Infant wide-field retinal image — 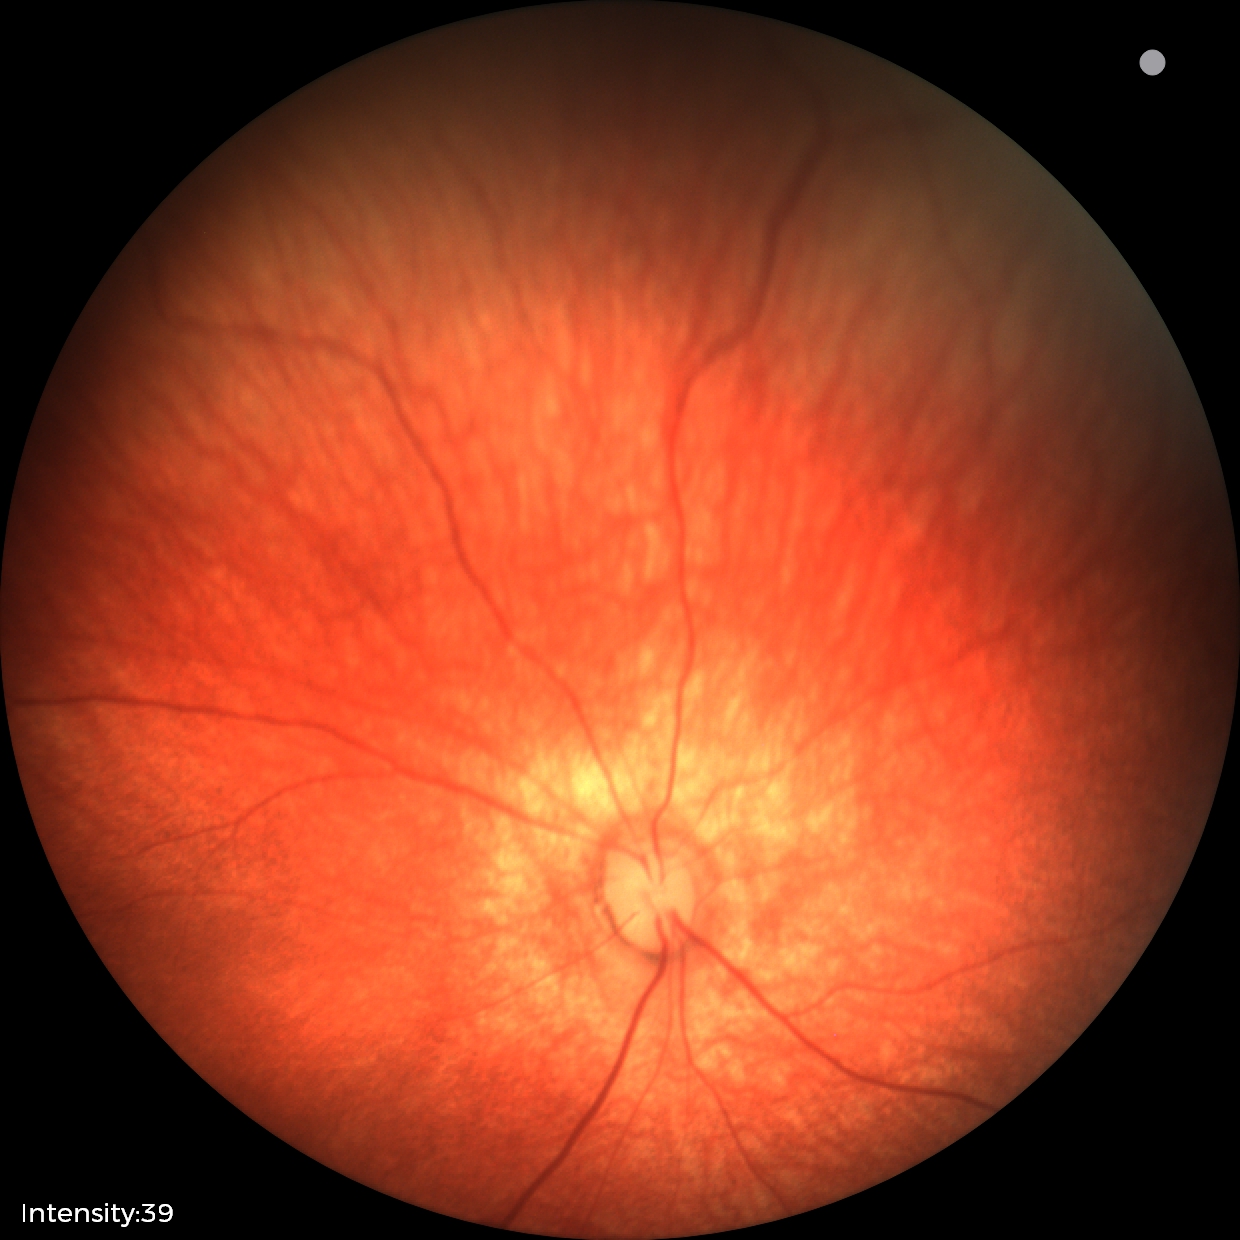
Normal screening examination.